45° FOV. 2352 x 1568 pixels:
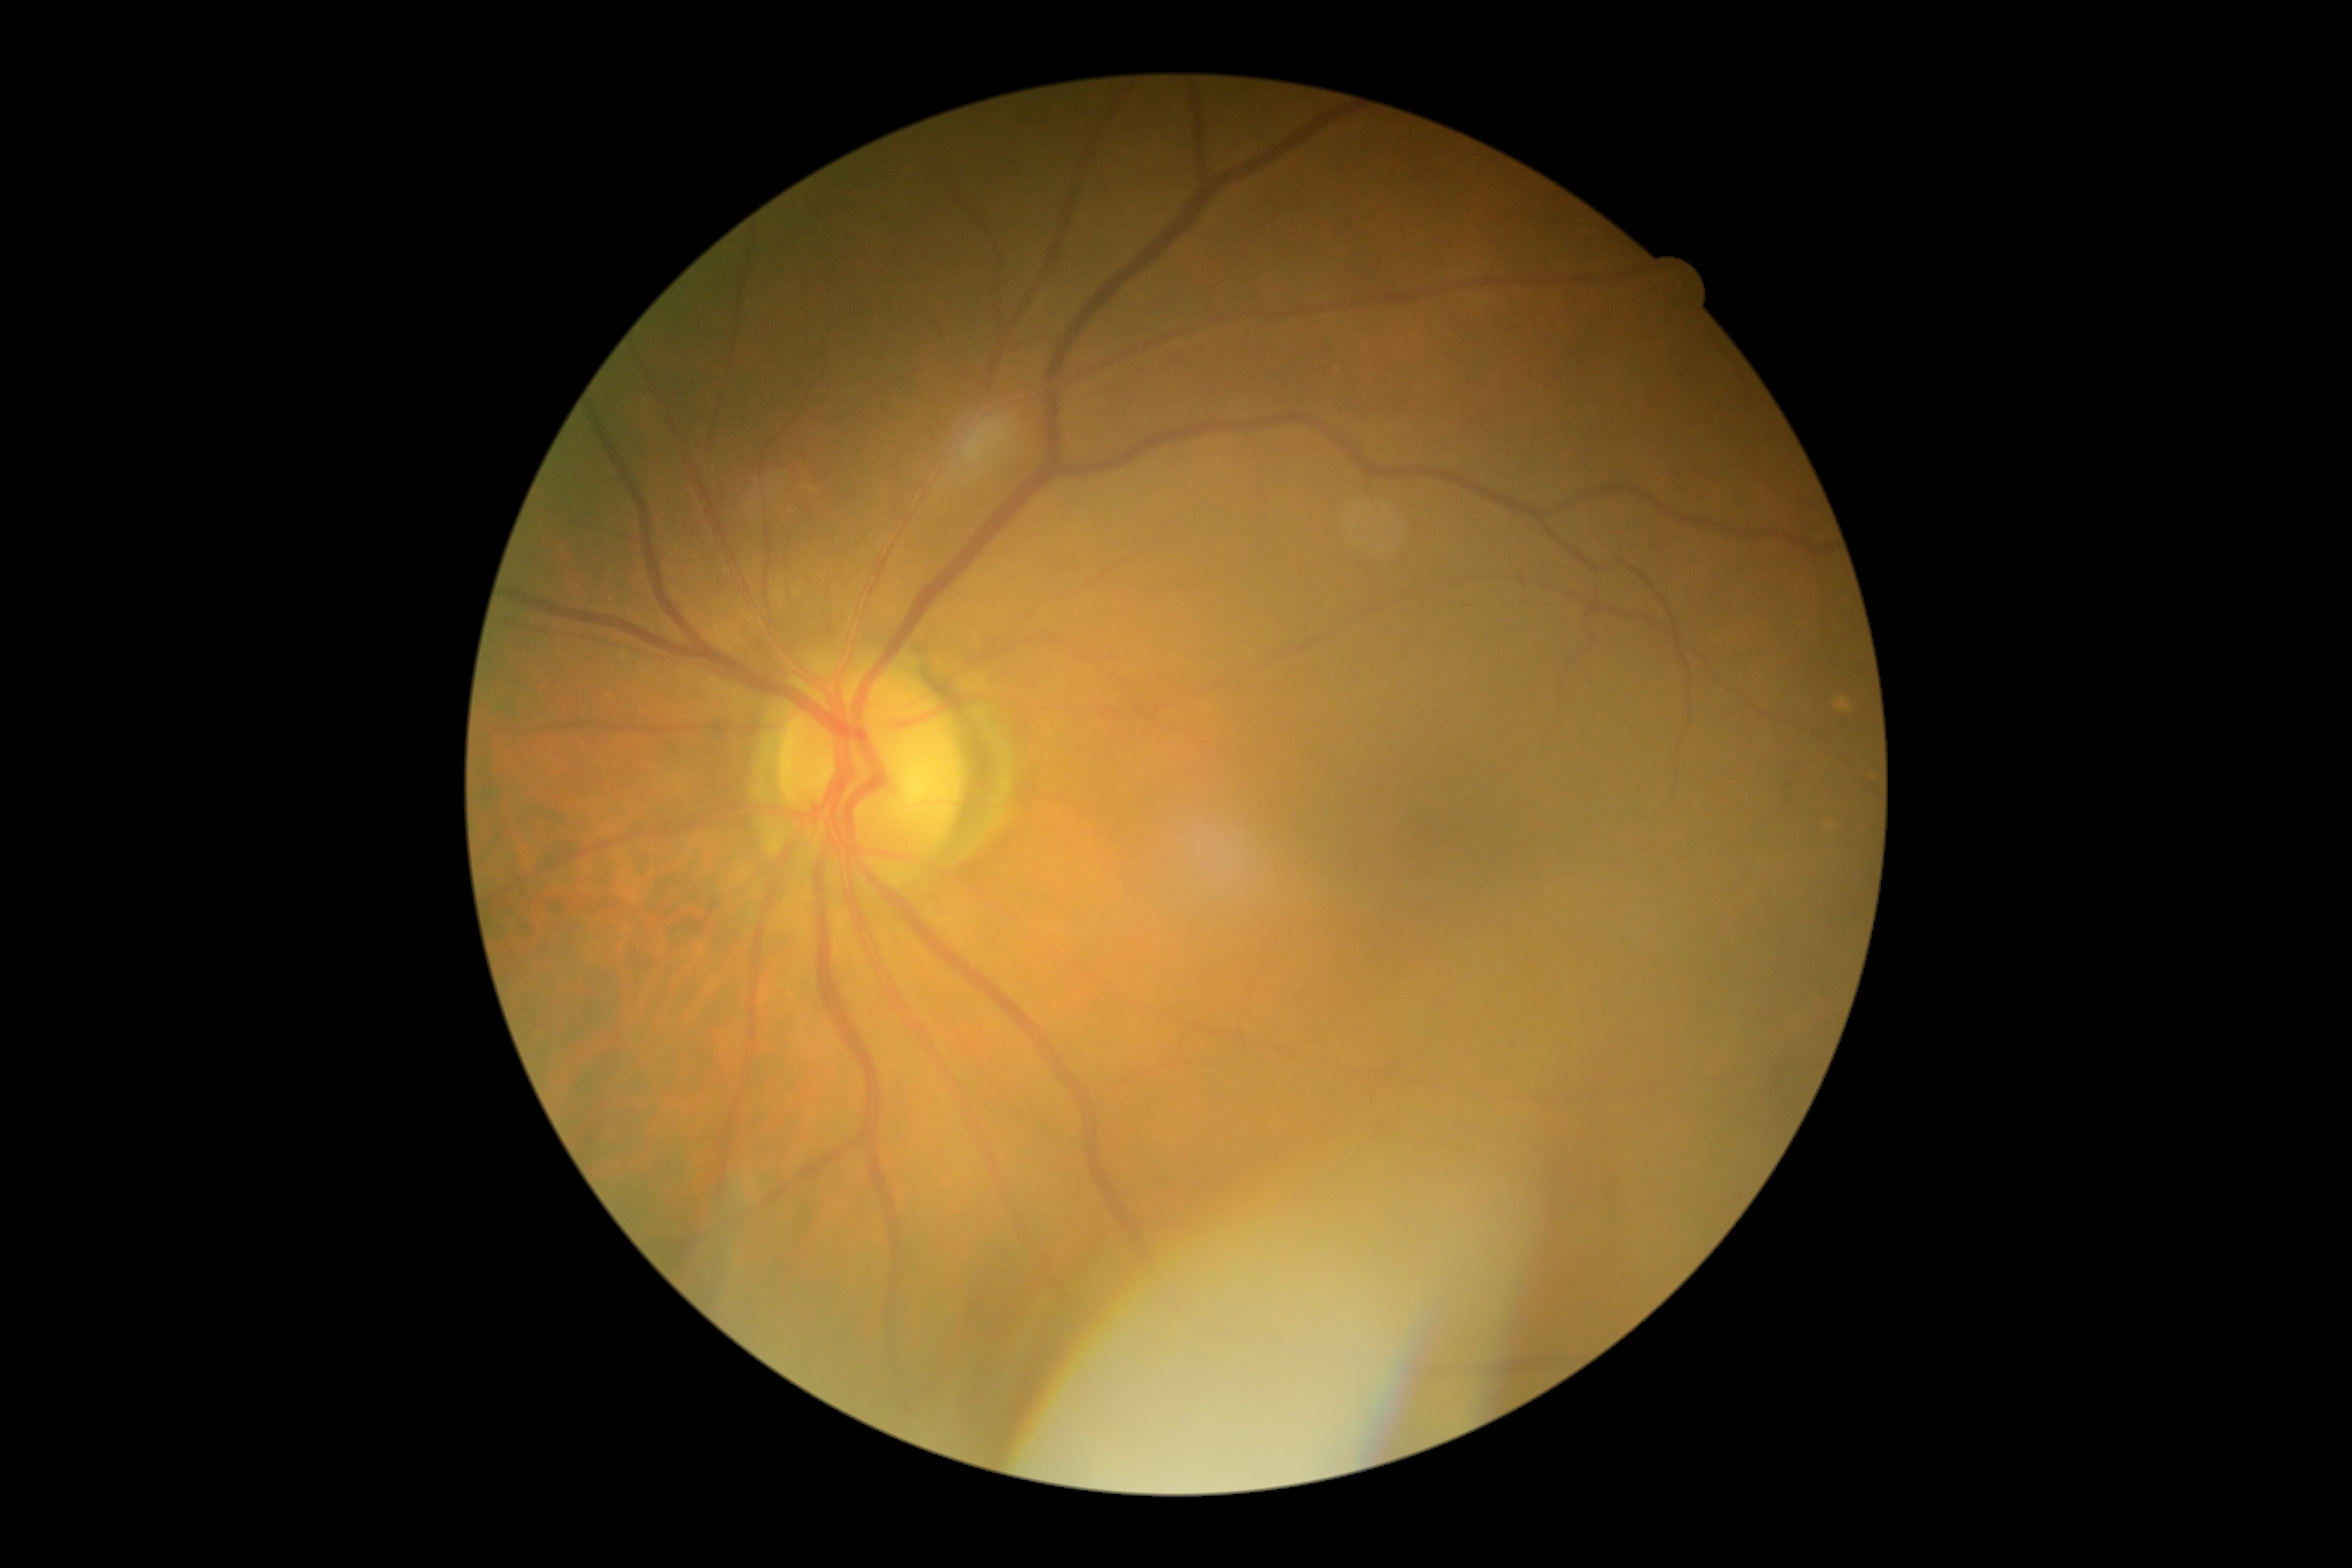 No apparent diabetic retinopathy. Diabetic retinopathy (DR): grade 0 (no apparent retinopathy) — no visible signs of diabetic retinopathy.